1440x1080px · wide-field contact fundus photograph of an infant.
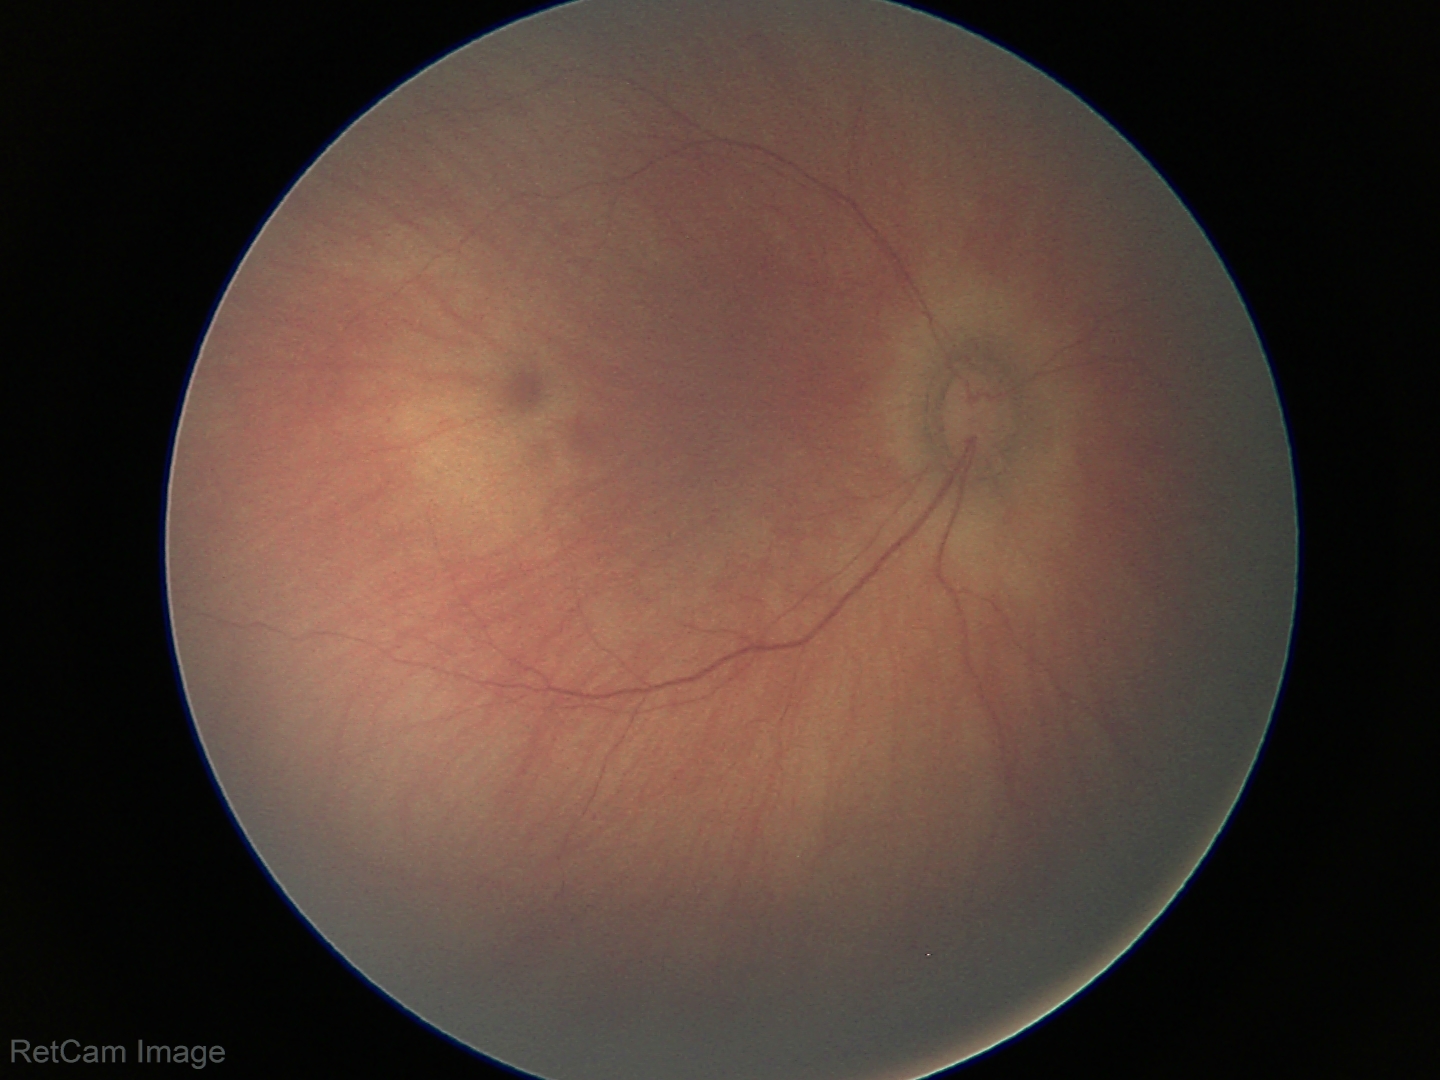 Screening: physiological retinal finding.